2089x1764:
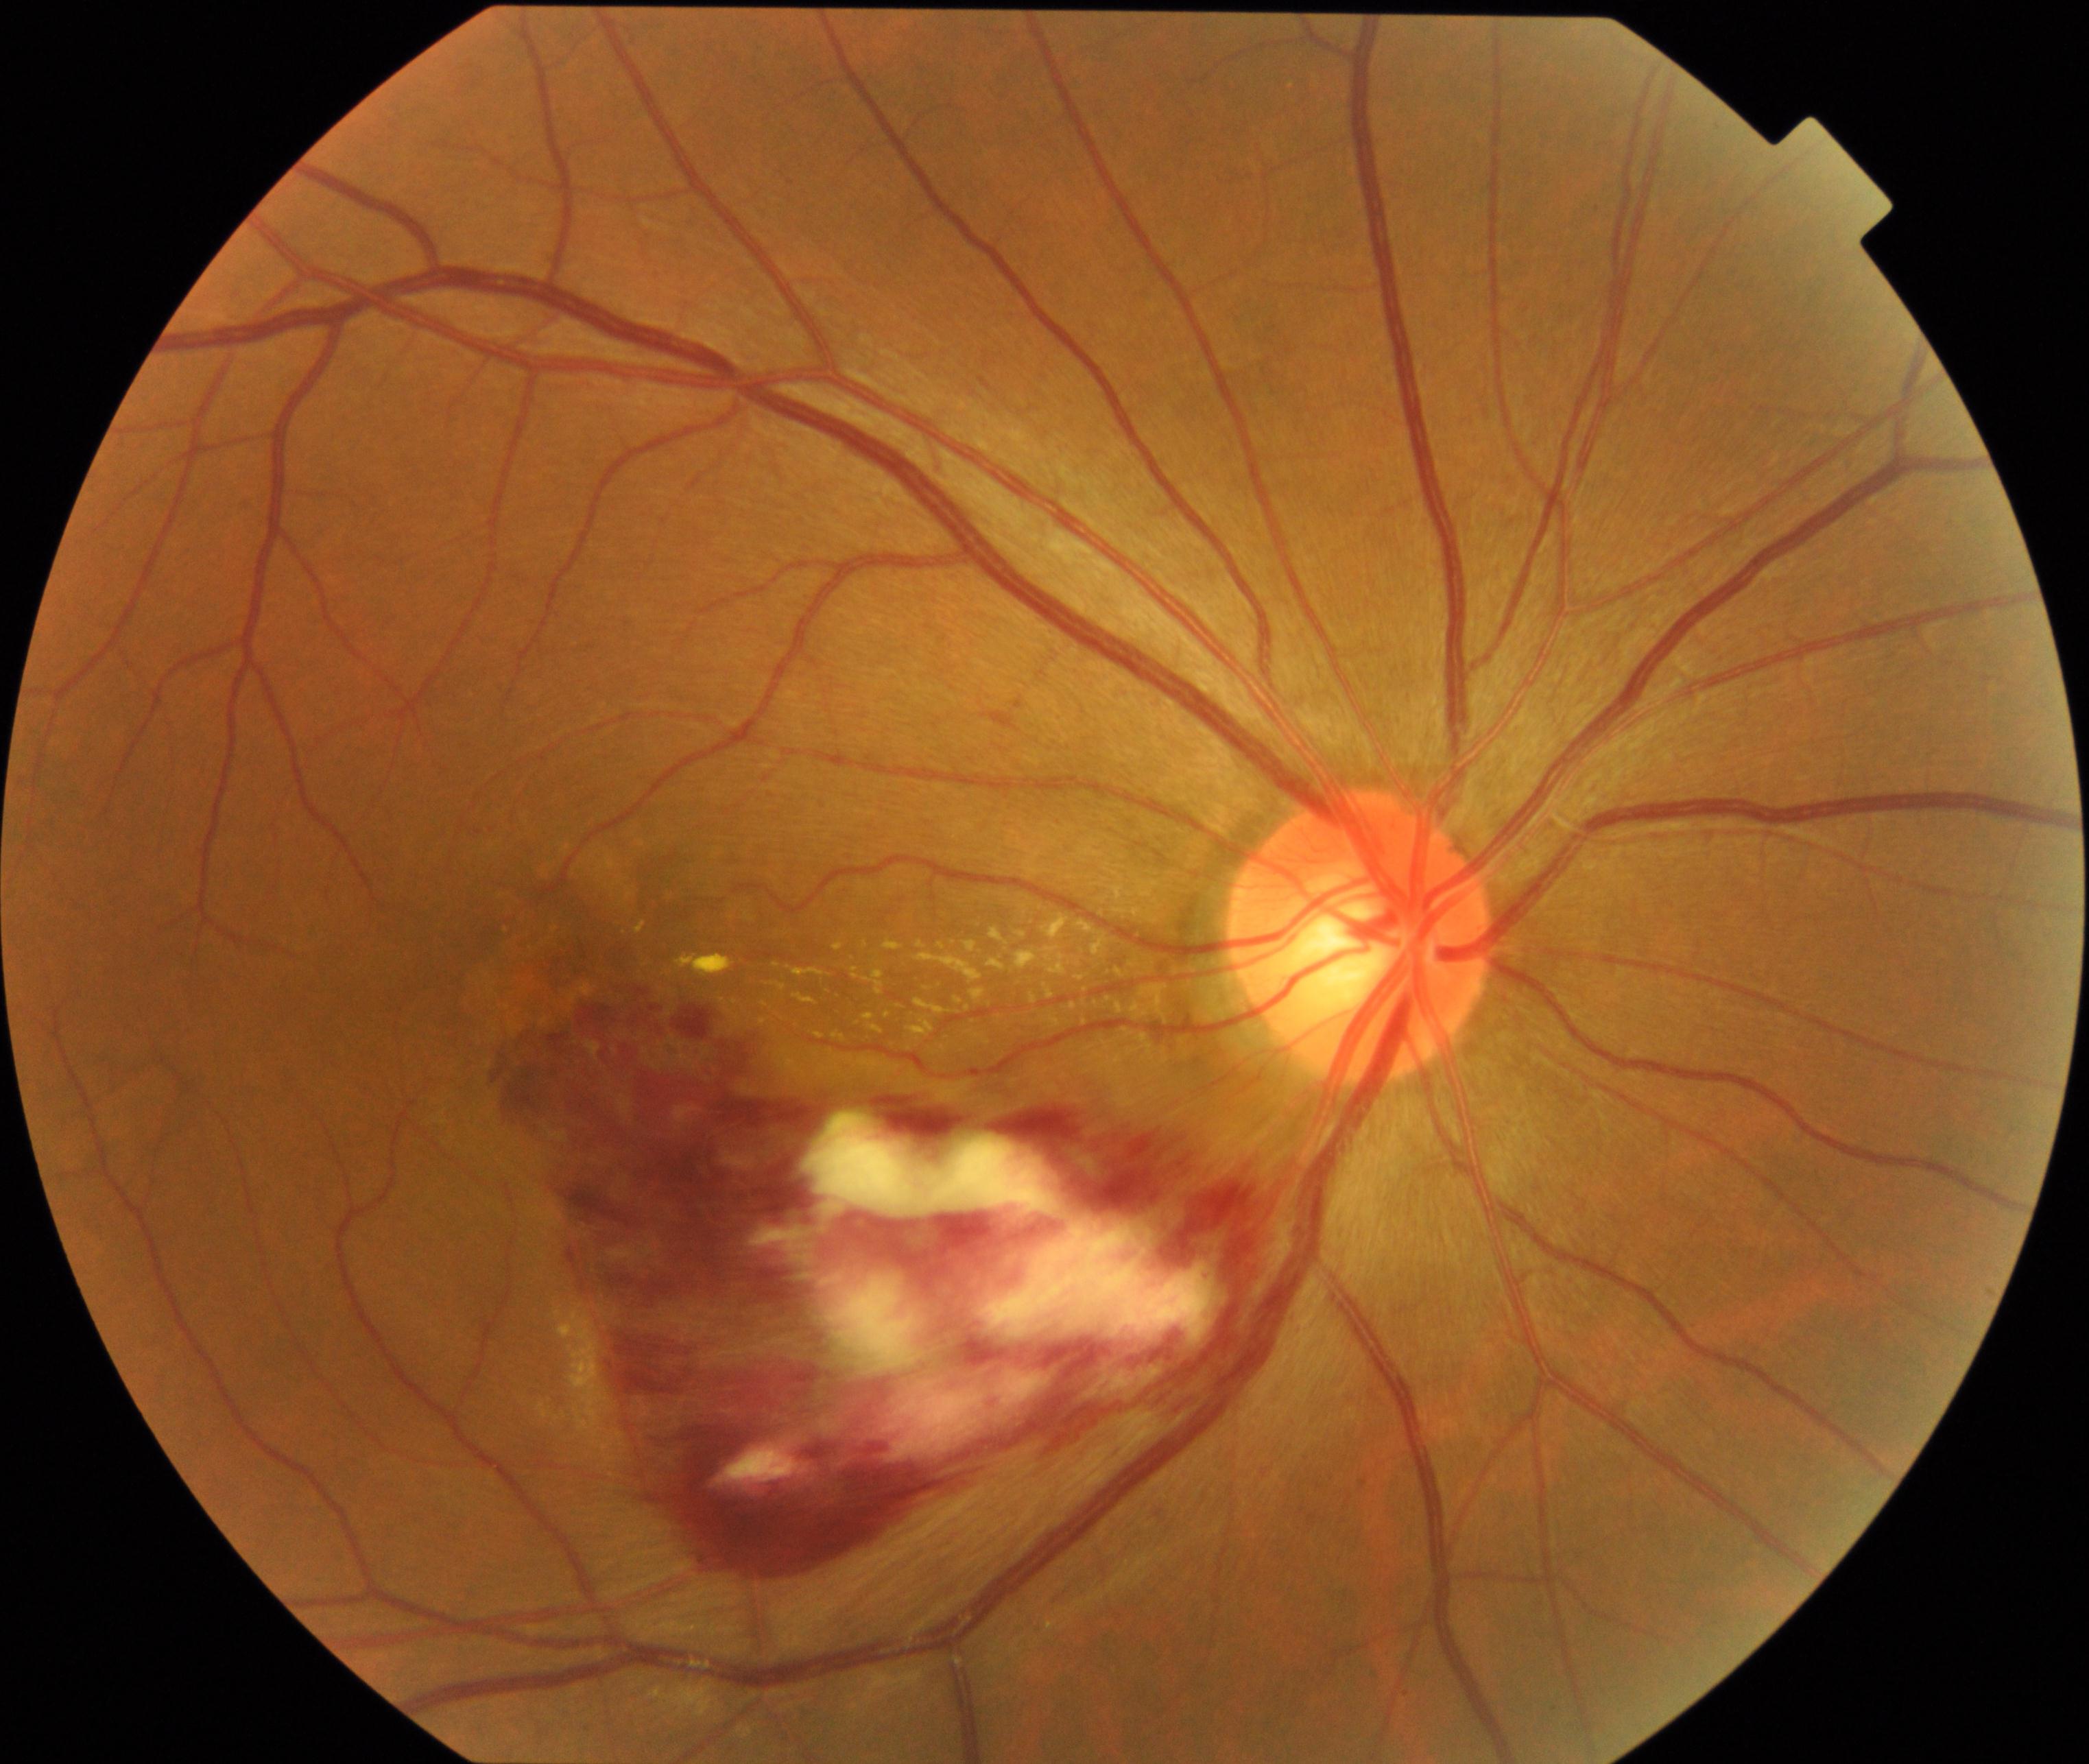 Diagnosis: branch retinal vein occlusion (BRVO).